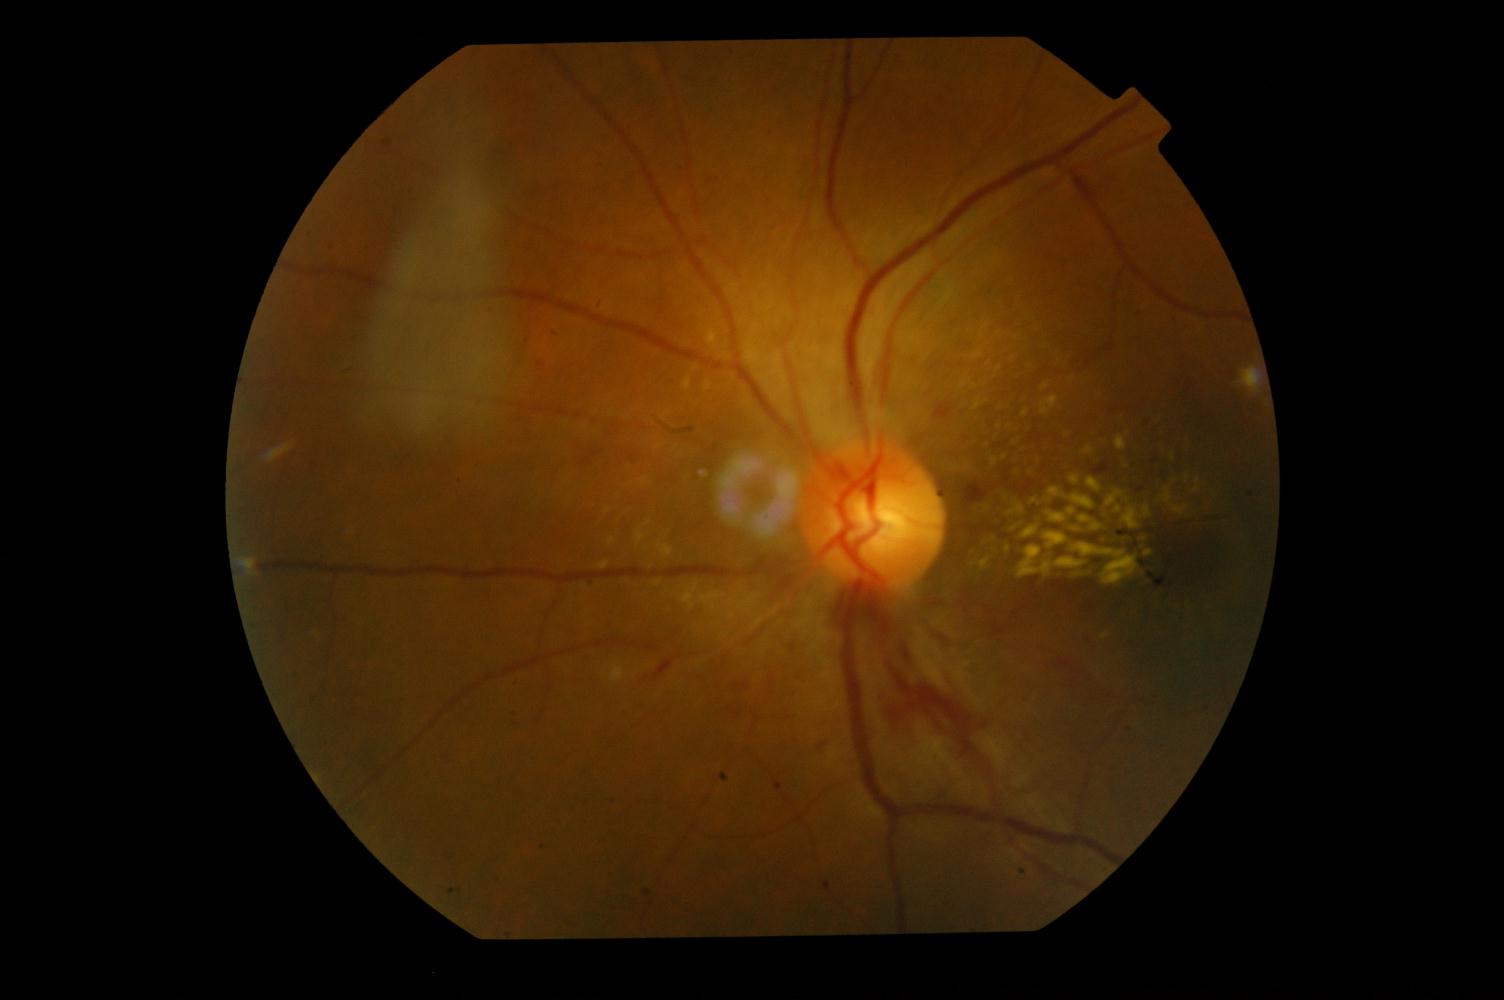

Color fundus photograph showing hypertensive retinopathy (HTN).